DR severity per modified Davis staging: 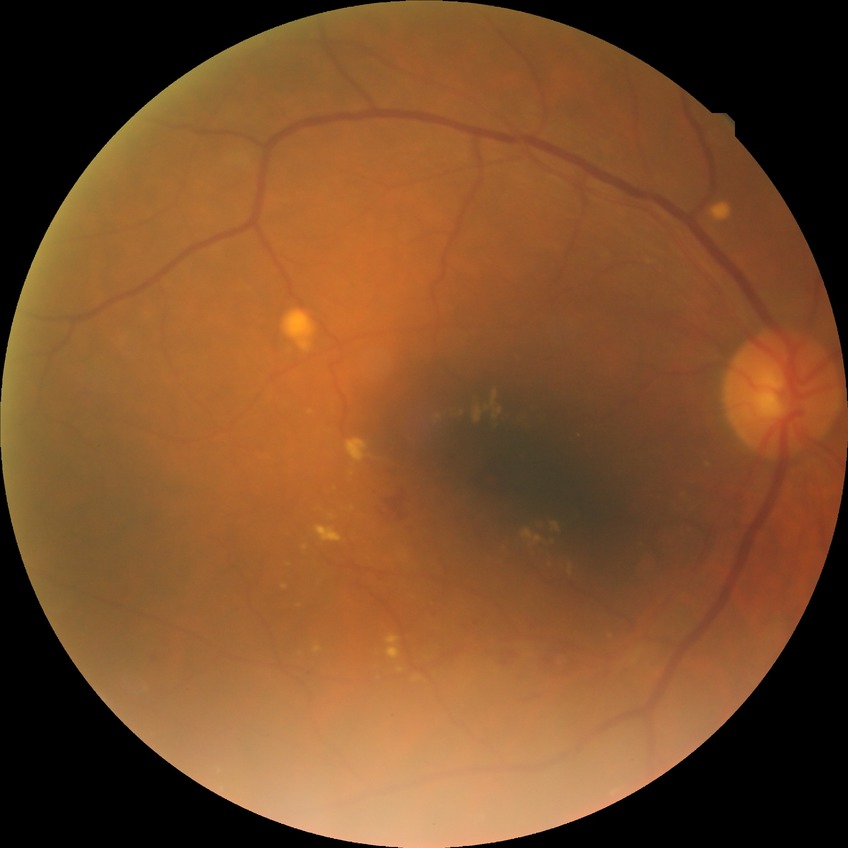
{
  "davis_grade": "simple diabetic retinopathy (SDR)"
}